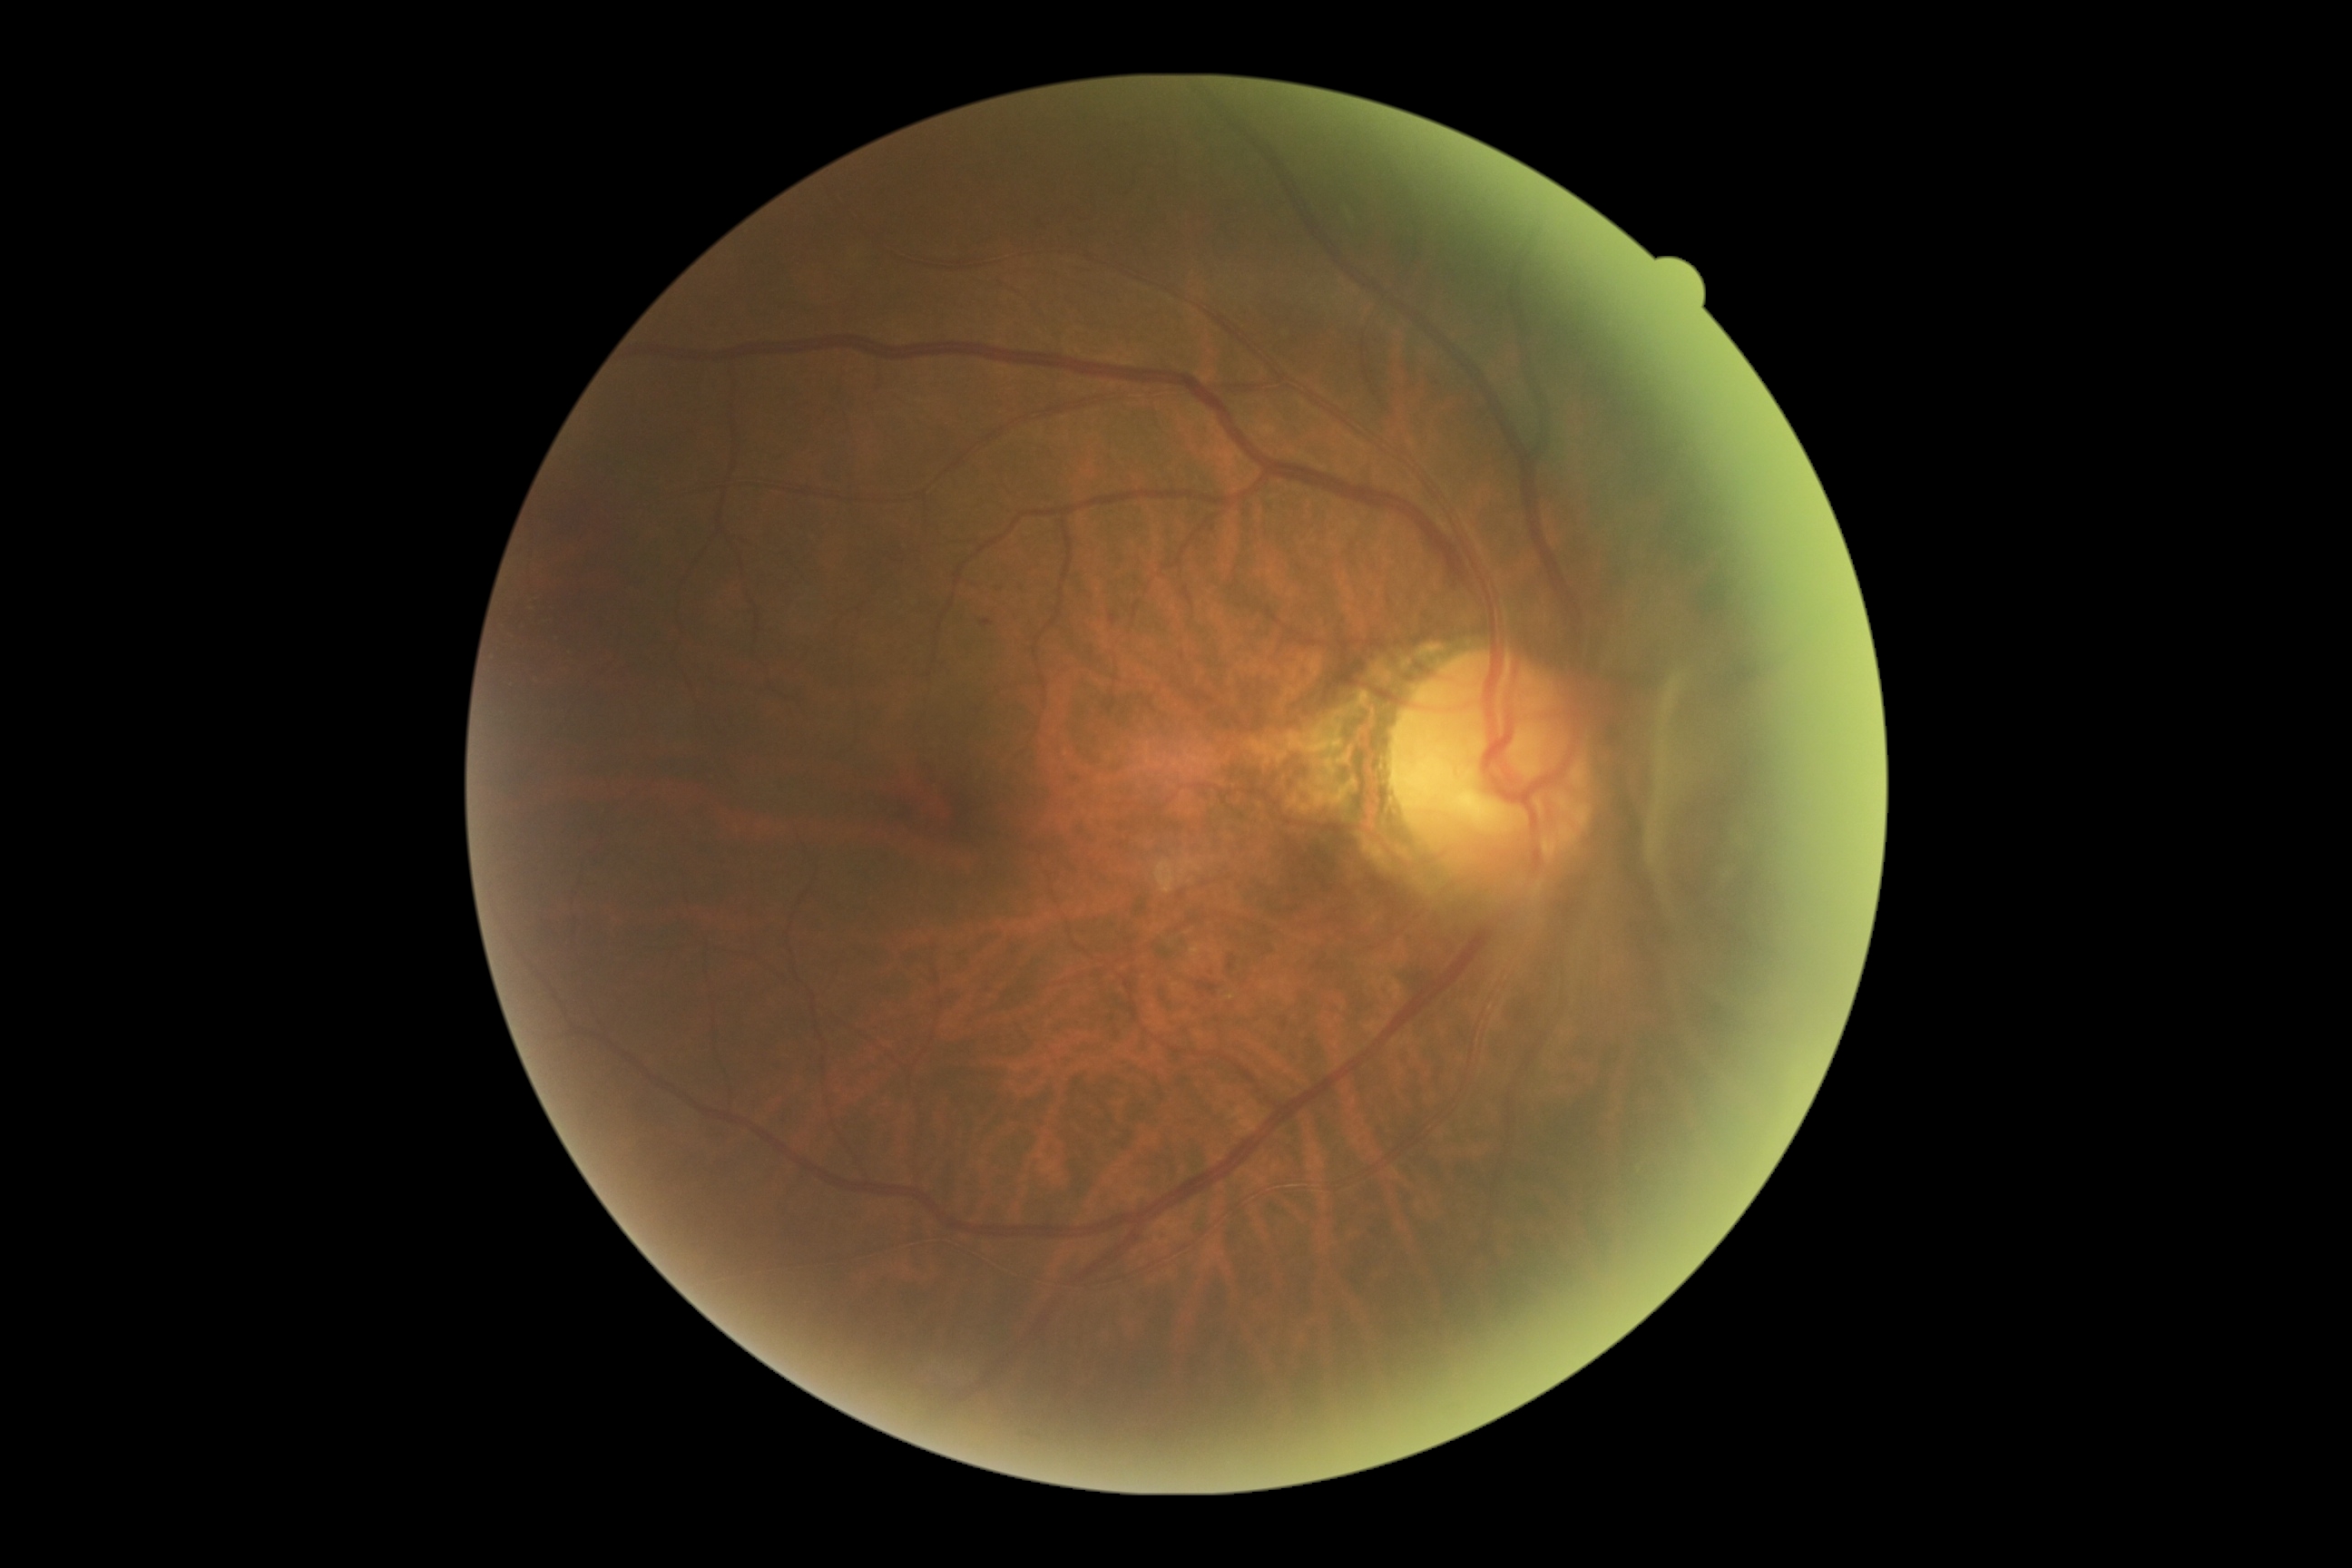
DR class = non-proliferative diabetic retinopathy, diabetic retinopathy severity = grade 2 (moderate NPDR).